45° field of view; modified Davis classification: 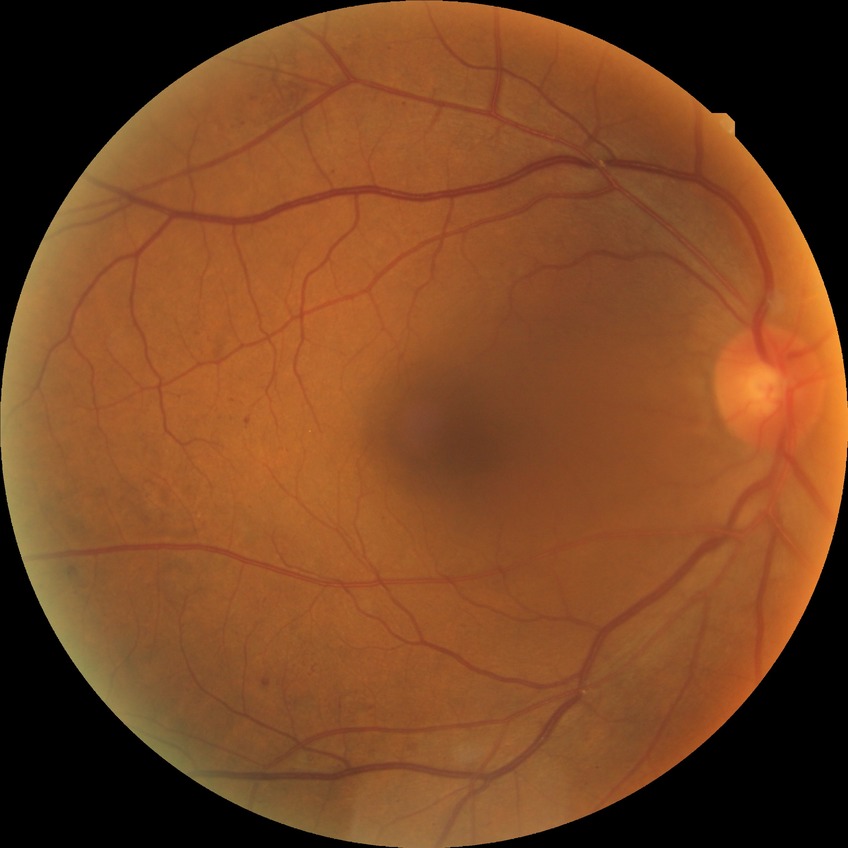 Diabetic retinopathy (DR) is simple diabetic retinopathy (SDR).